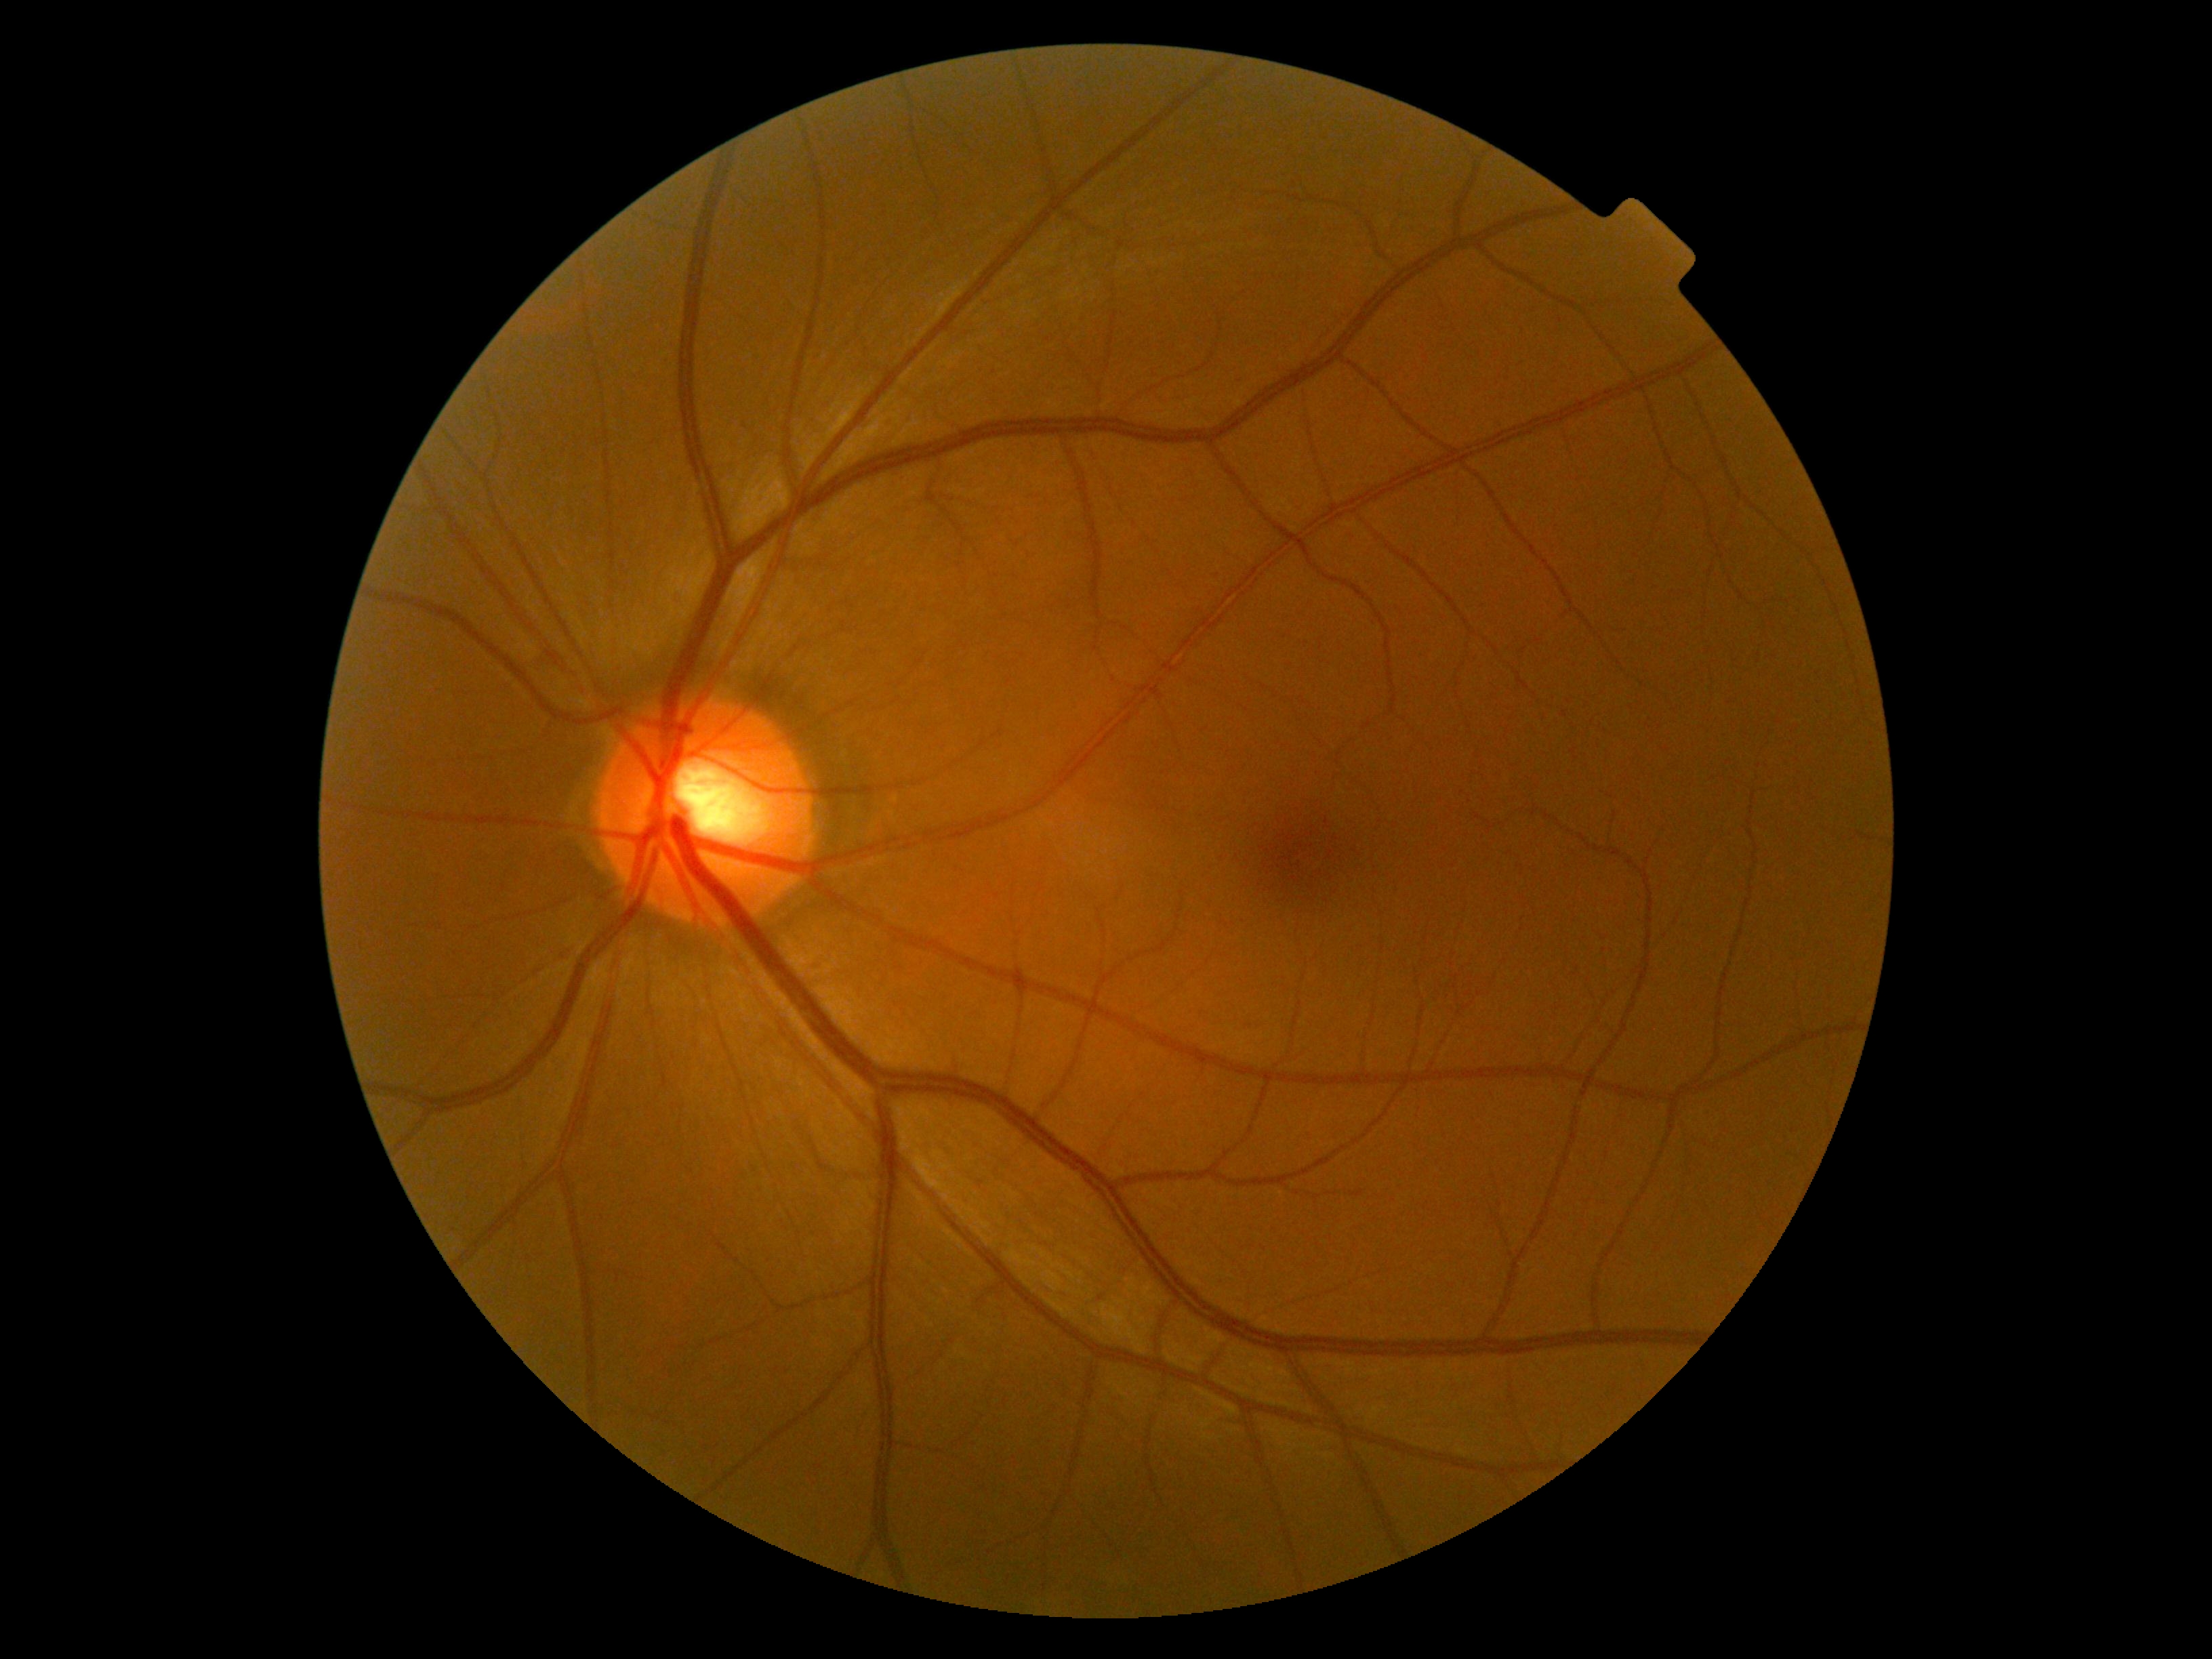 DR severity: 0/4 — no visible signs of diabetic retinopathy.